CFP. 45° FOV
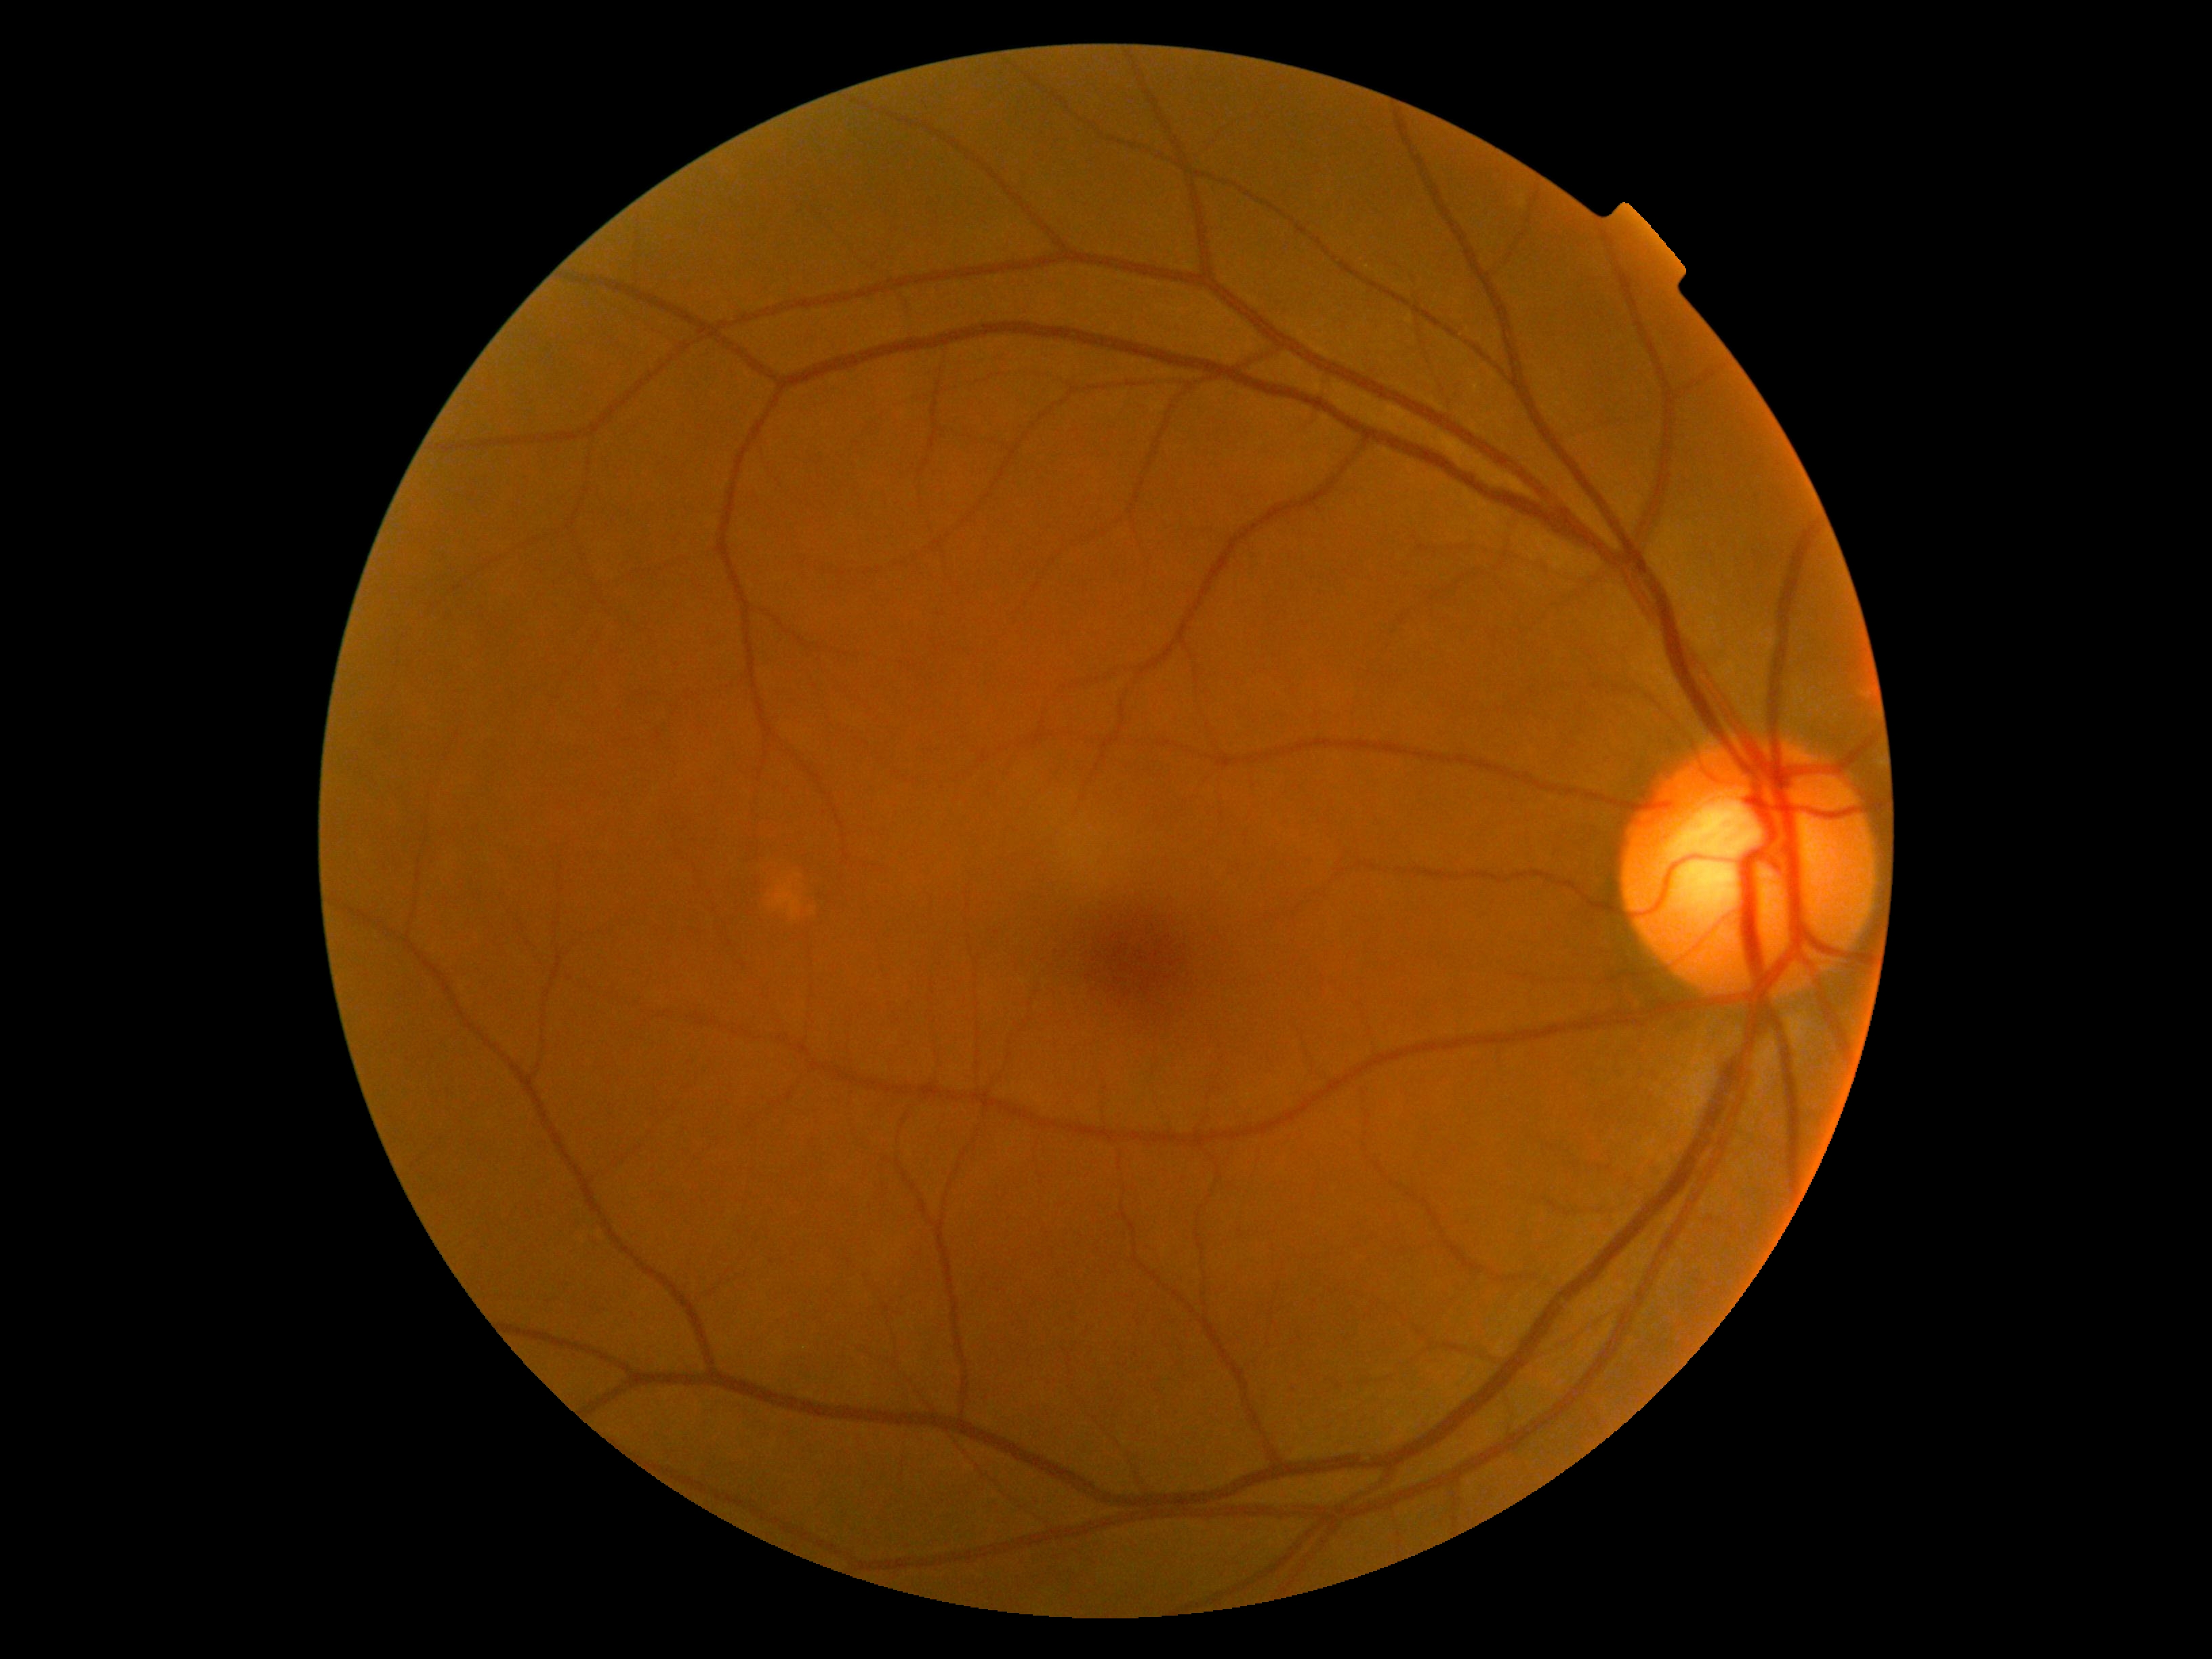
Findings:
- retinopathy — no apparent diabetic retinopathy (grade 0)